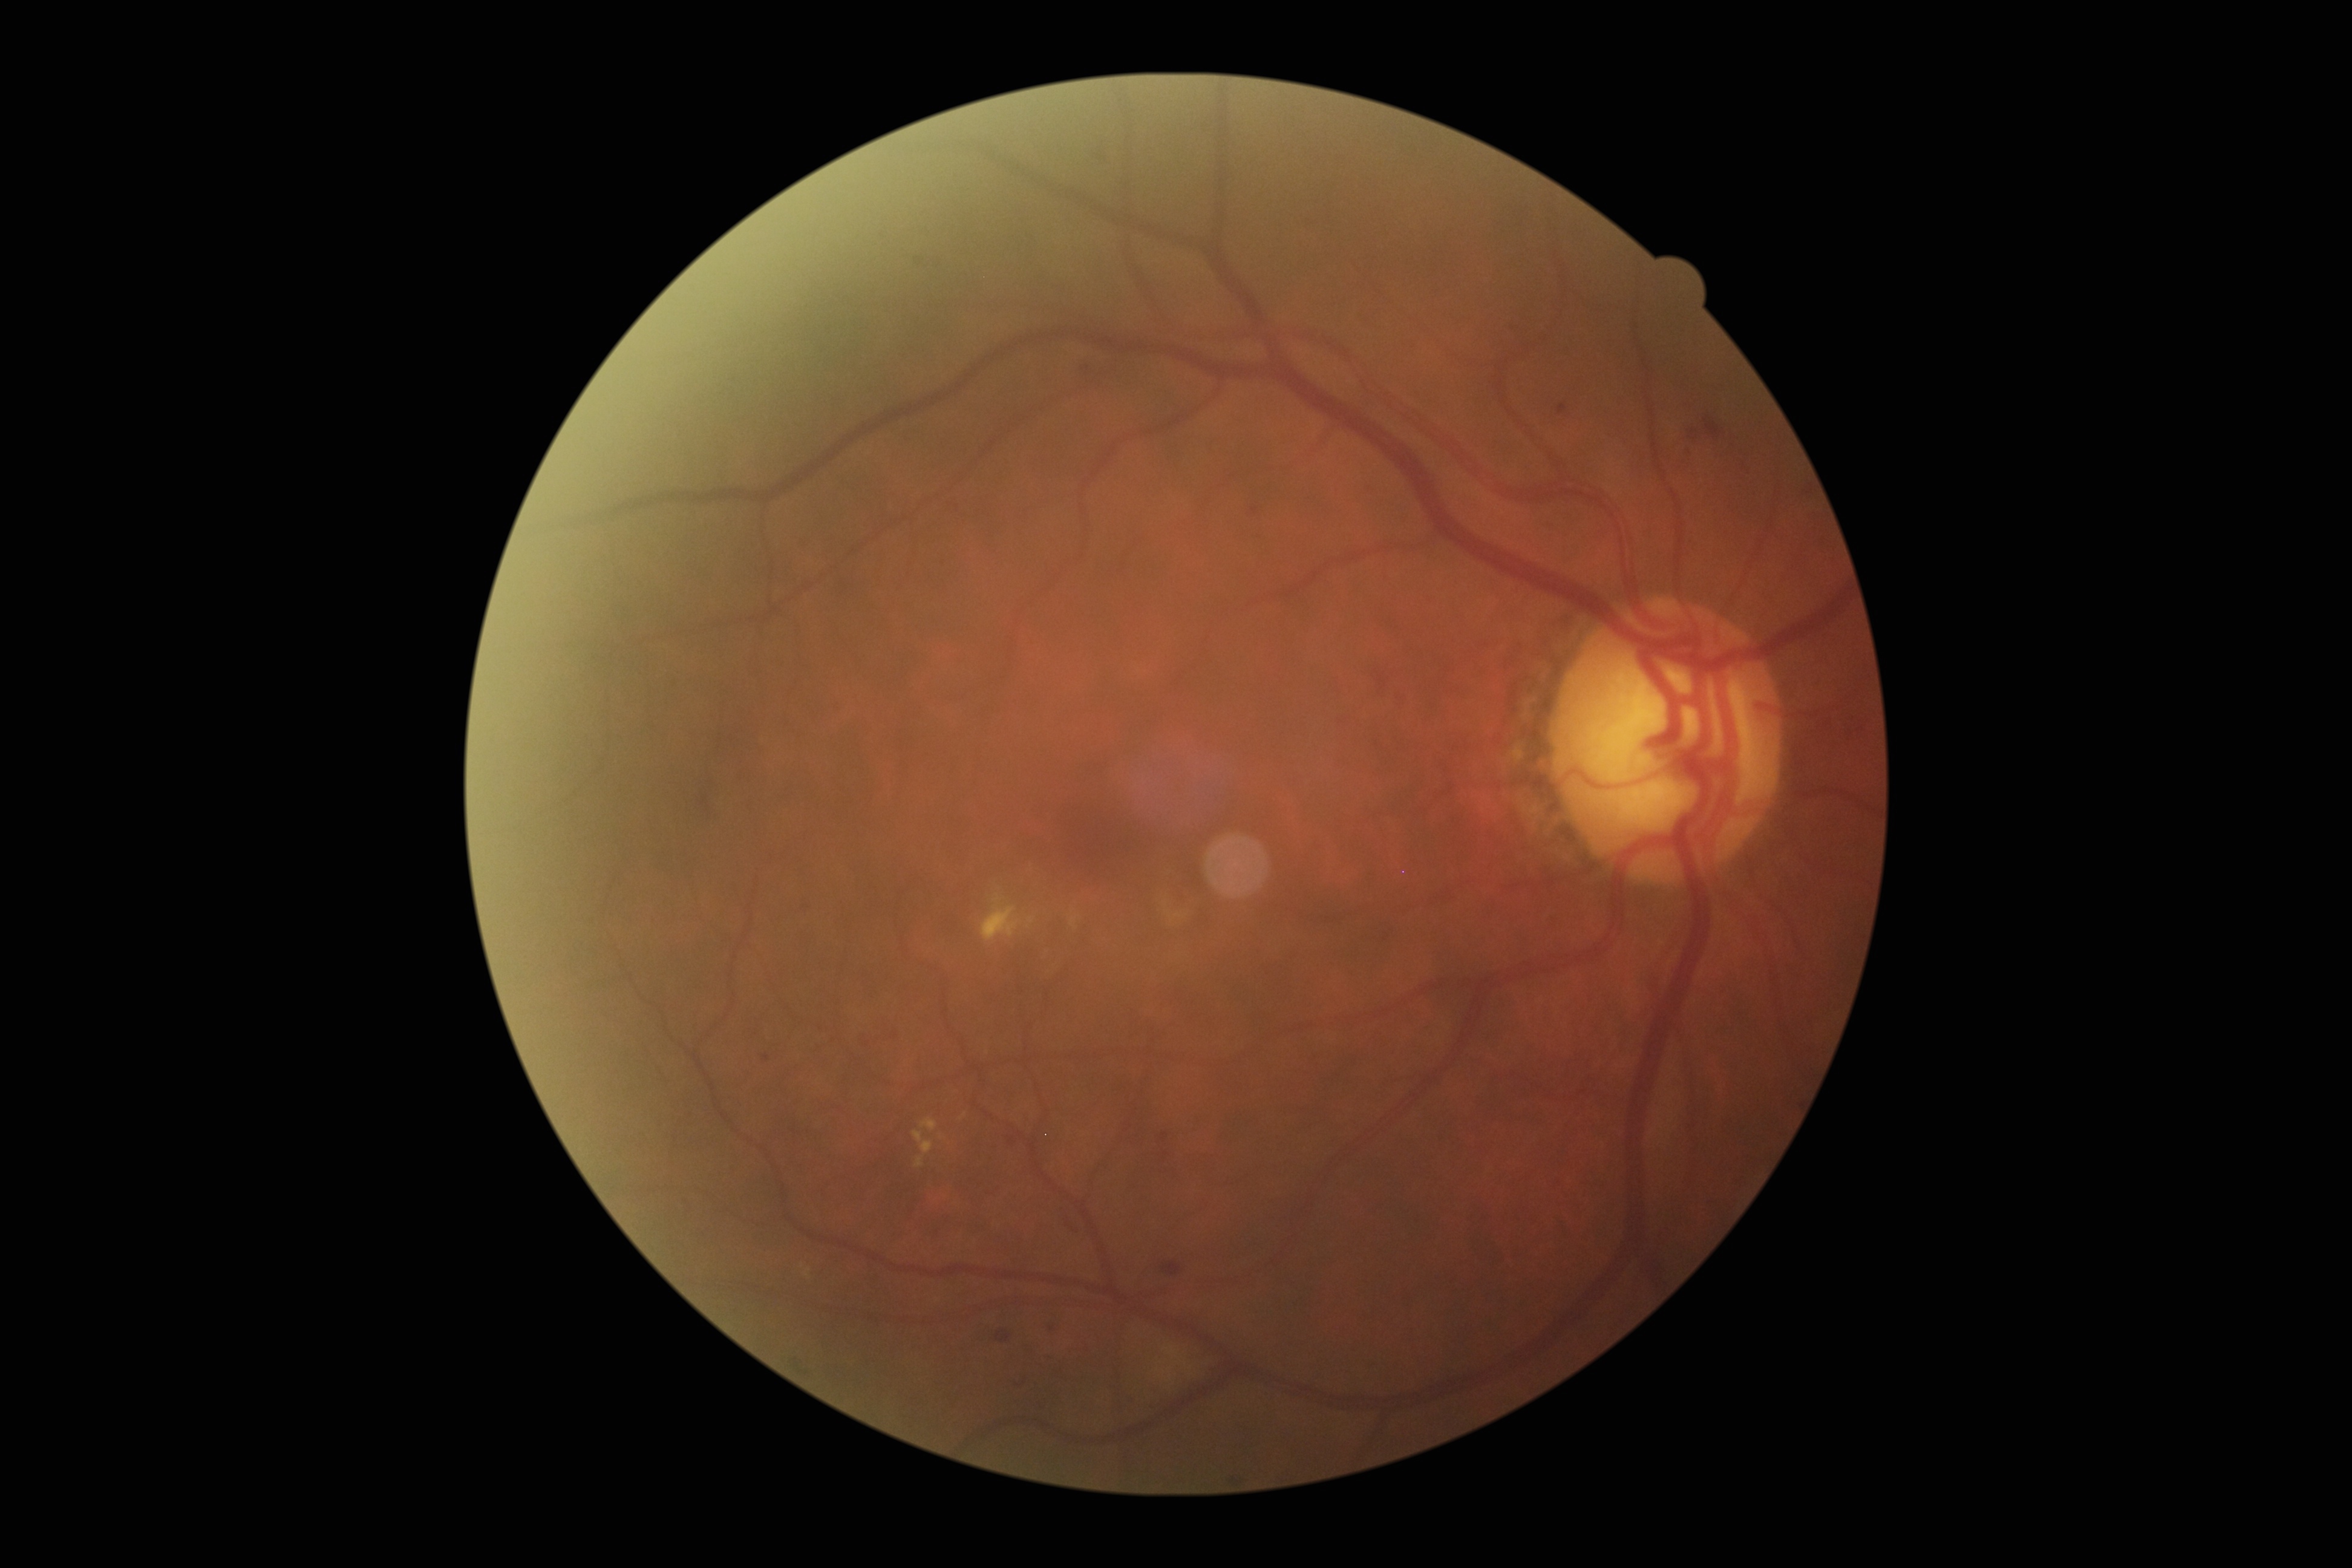
Retinopathy grade is 2 (moderate NPDR).